2352x1568.
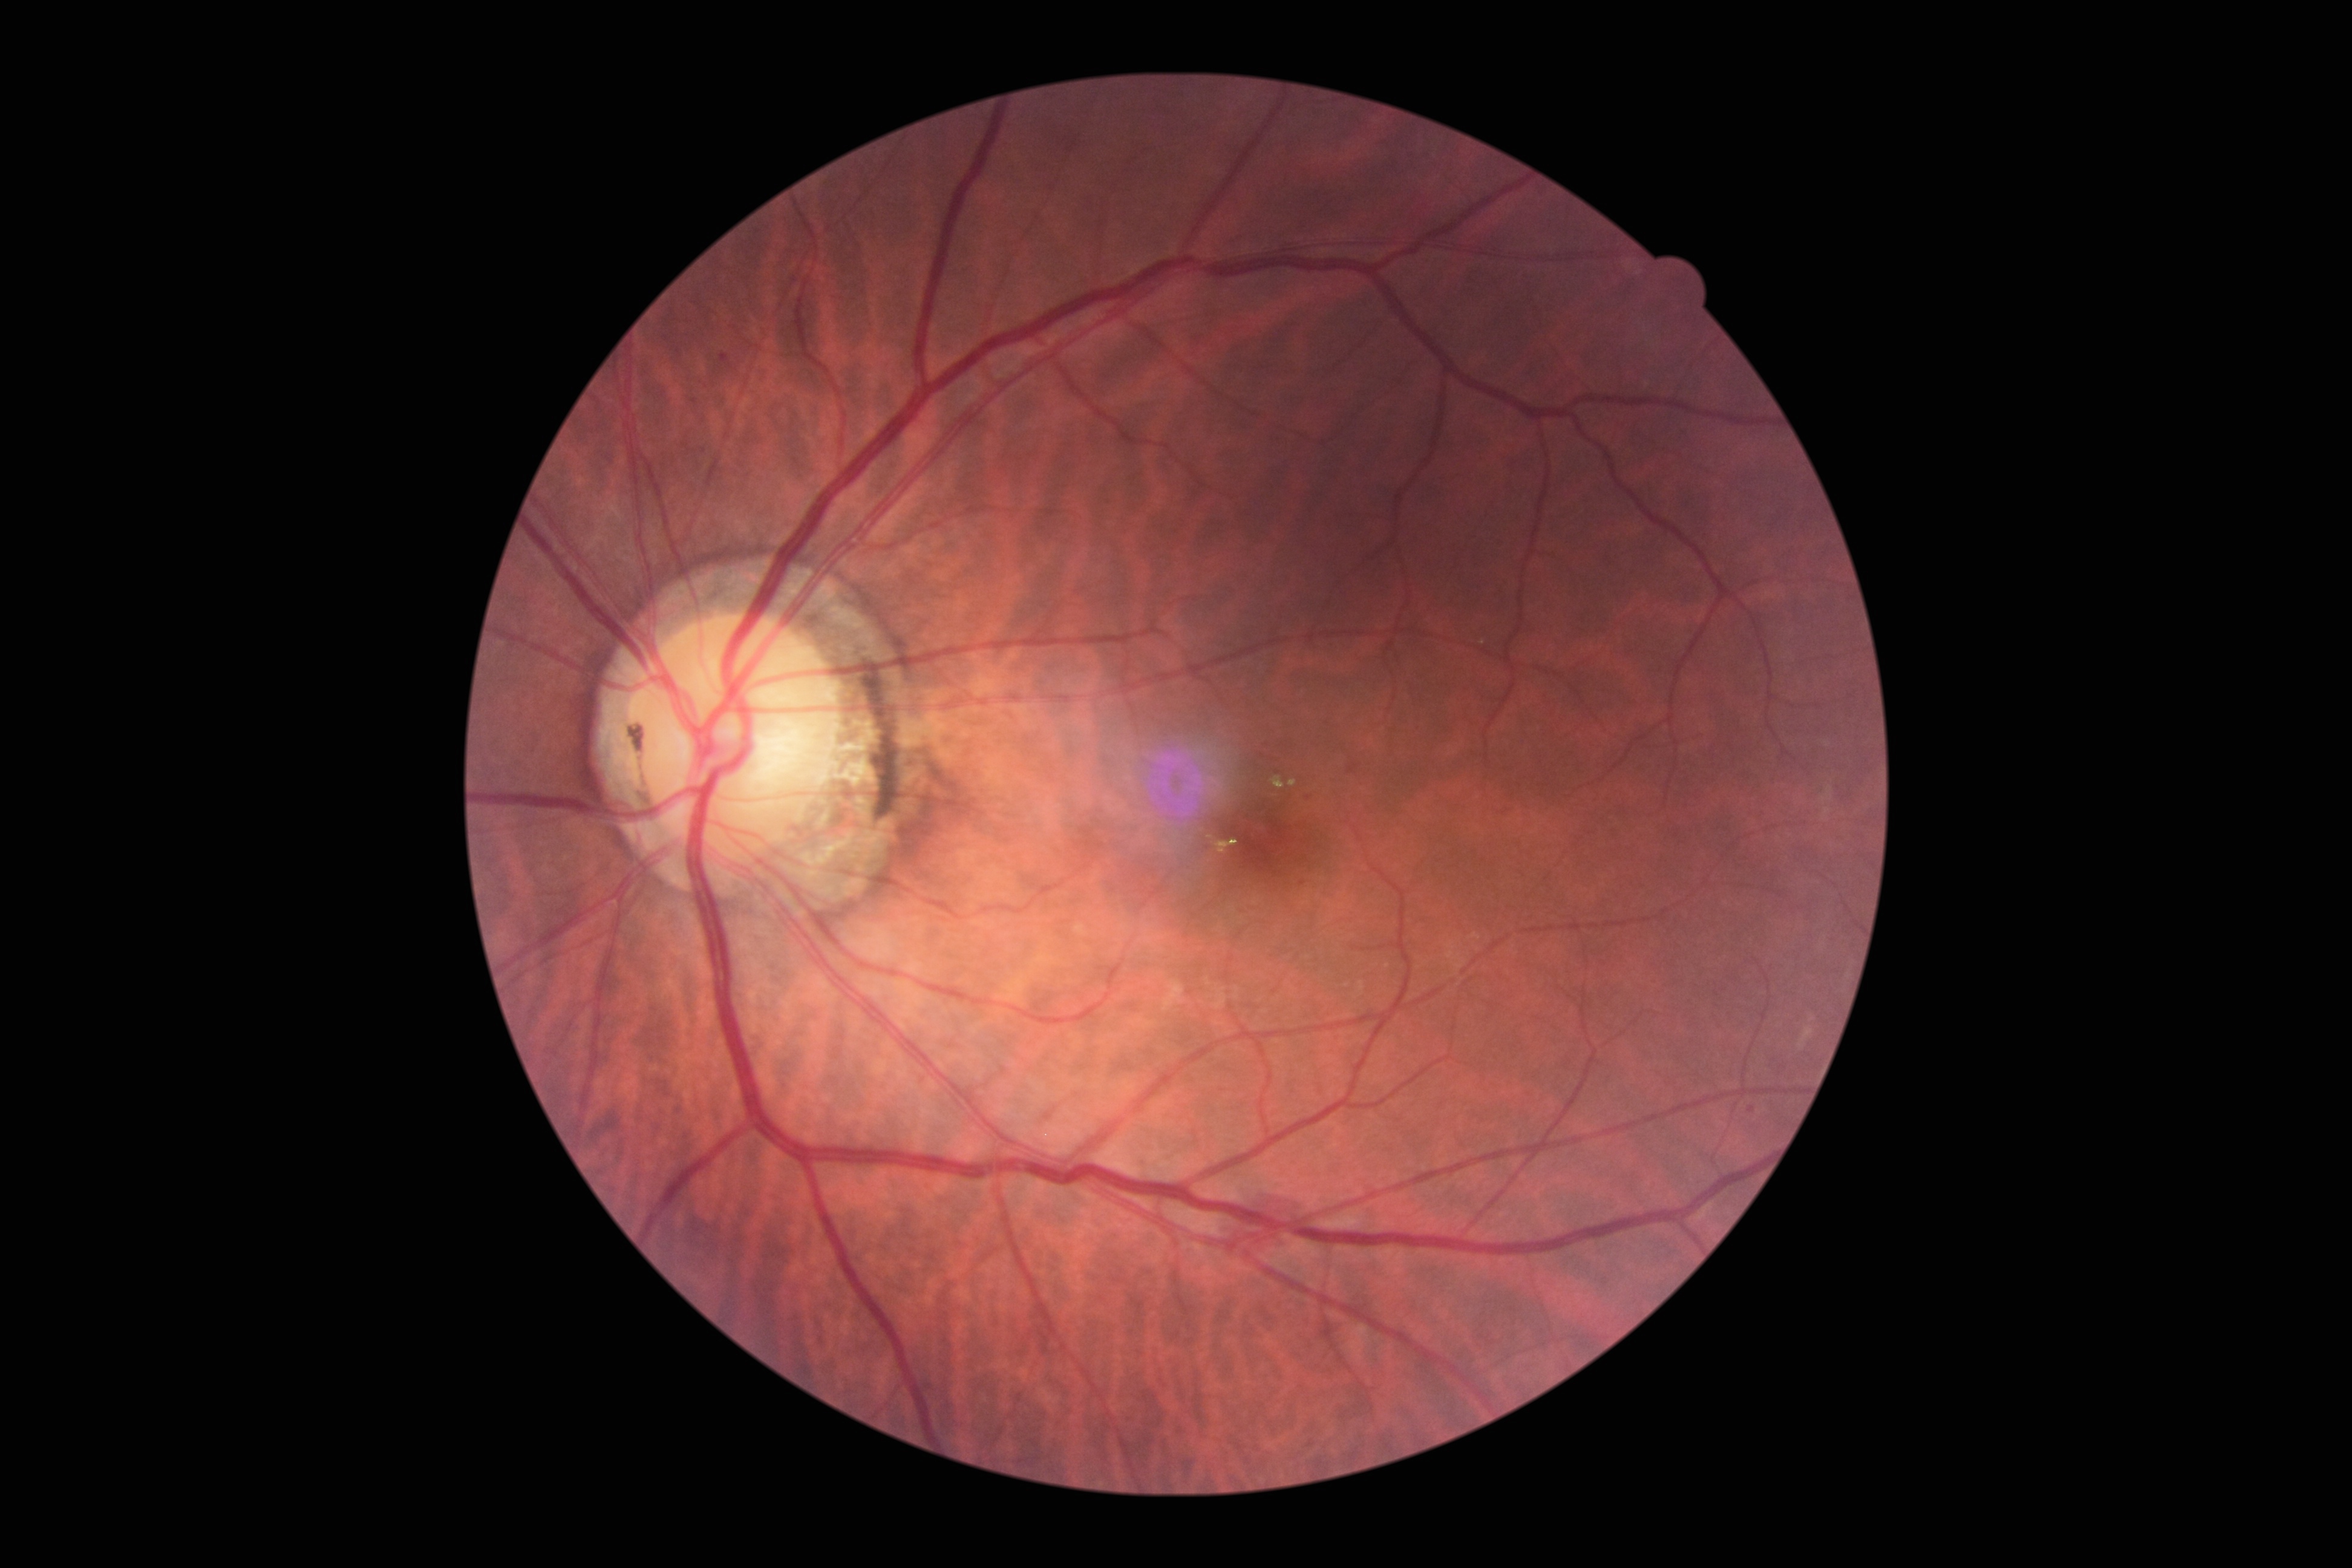
Diabetic retinopathy (DR): 2.